Davis DR grading. Camera: NIDEK AFC-230.
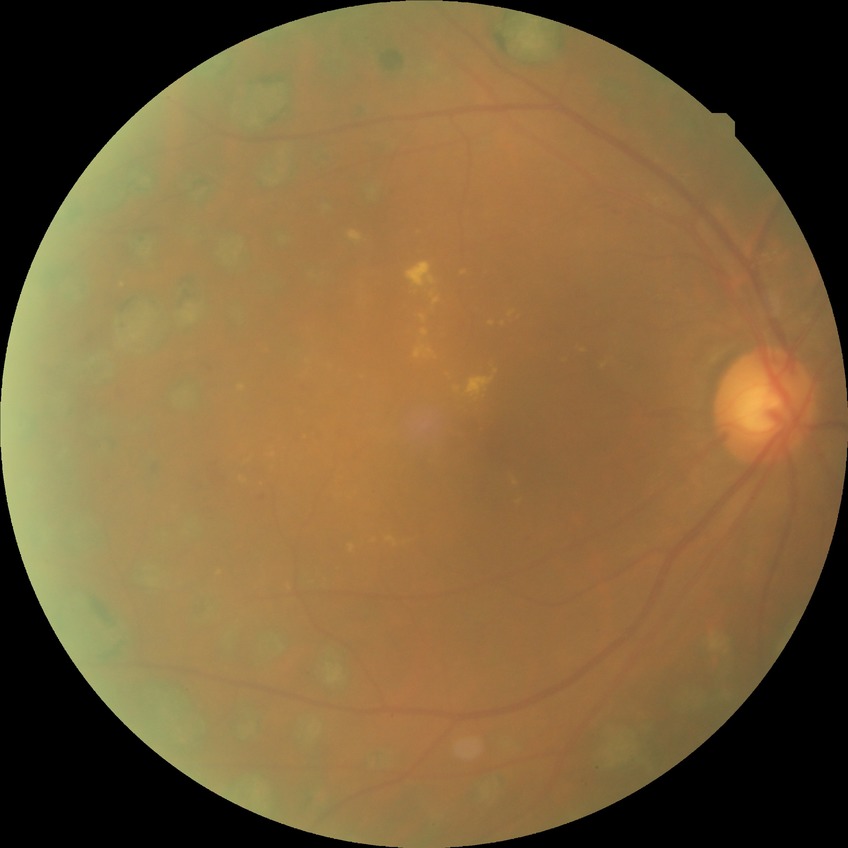
Diabetic retinopathy (DR): PDR (proliferative diabetic retinopathy).